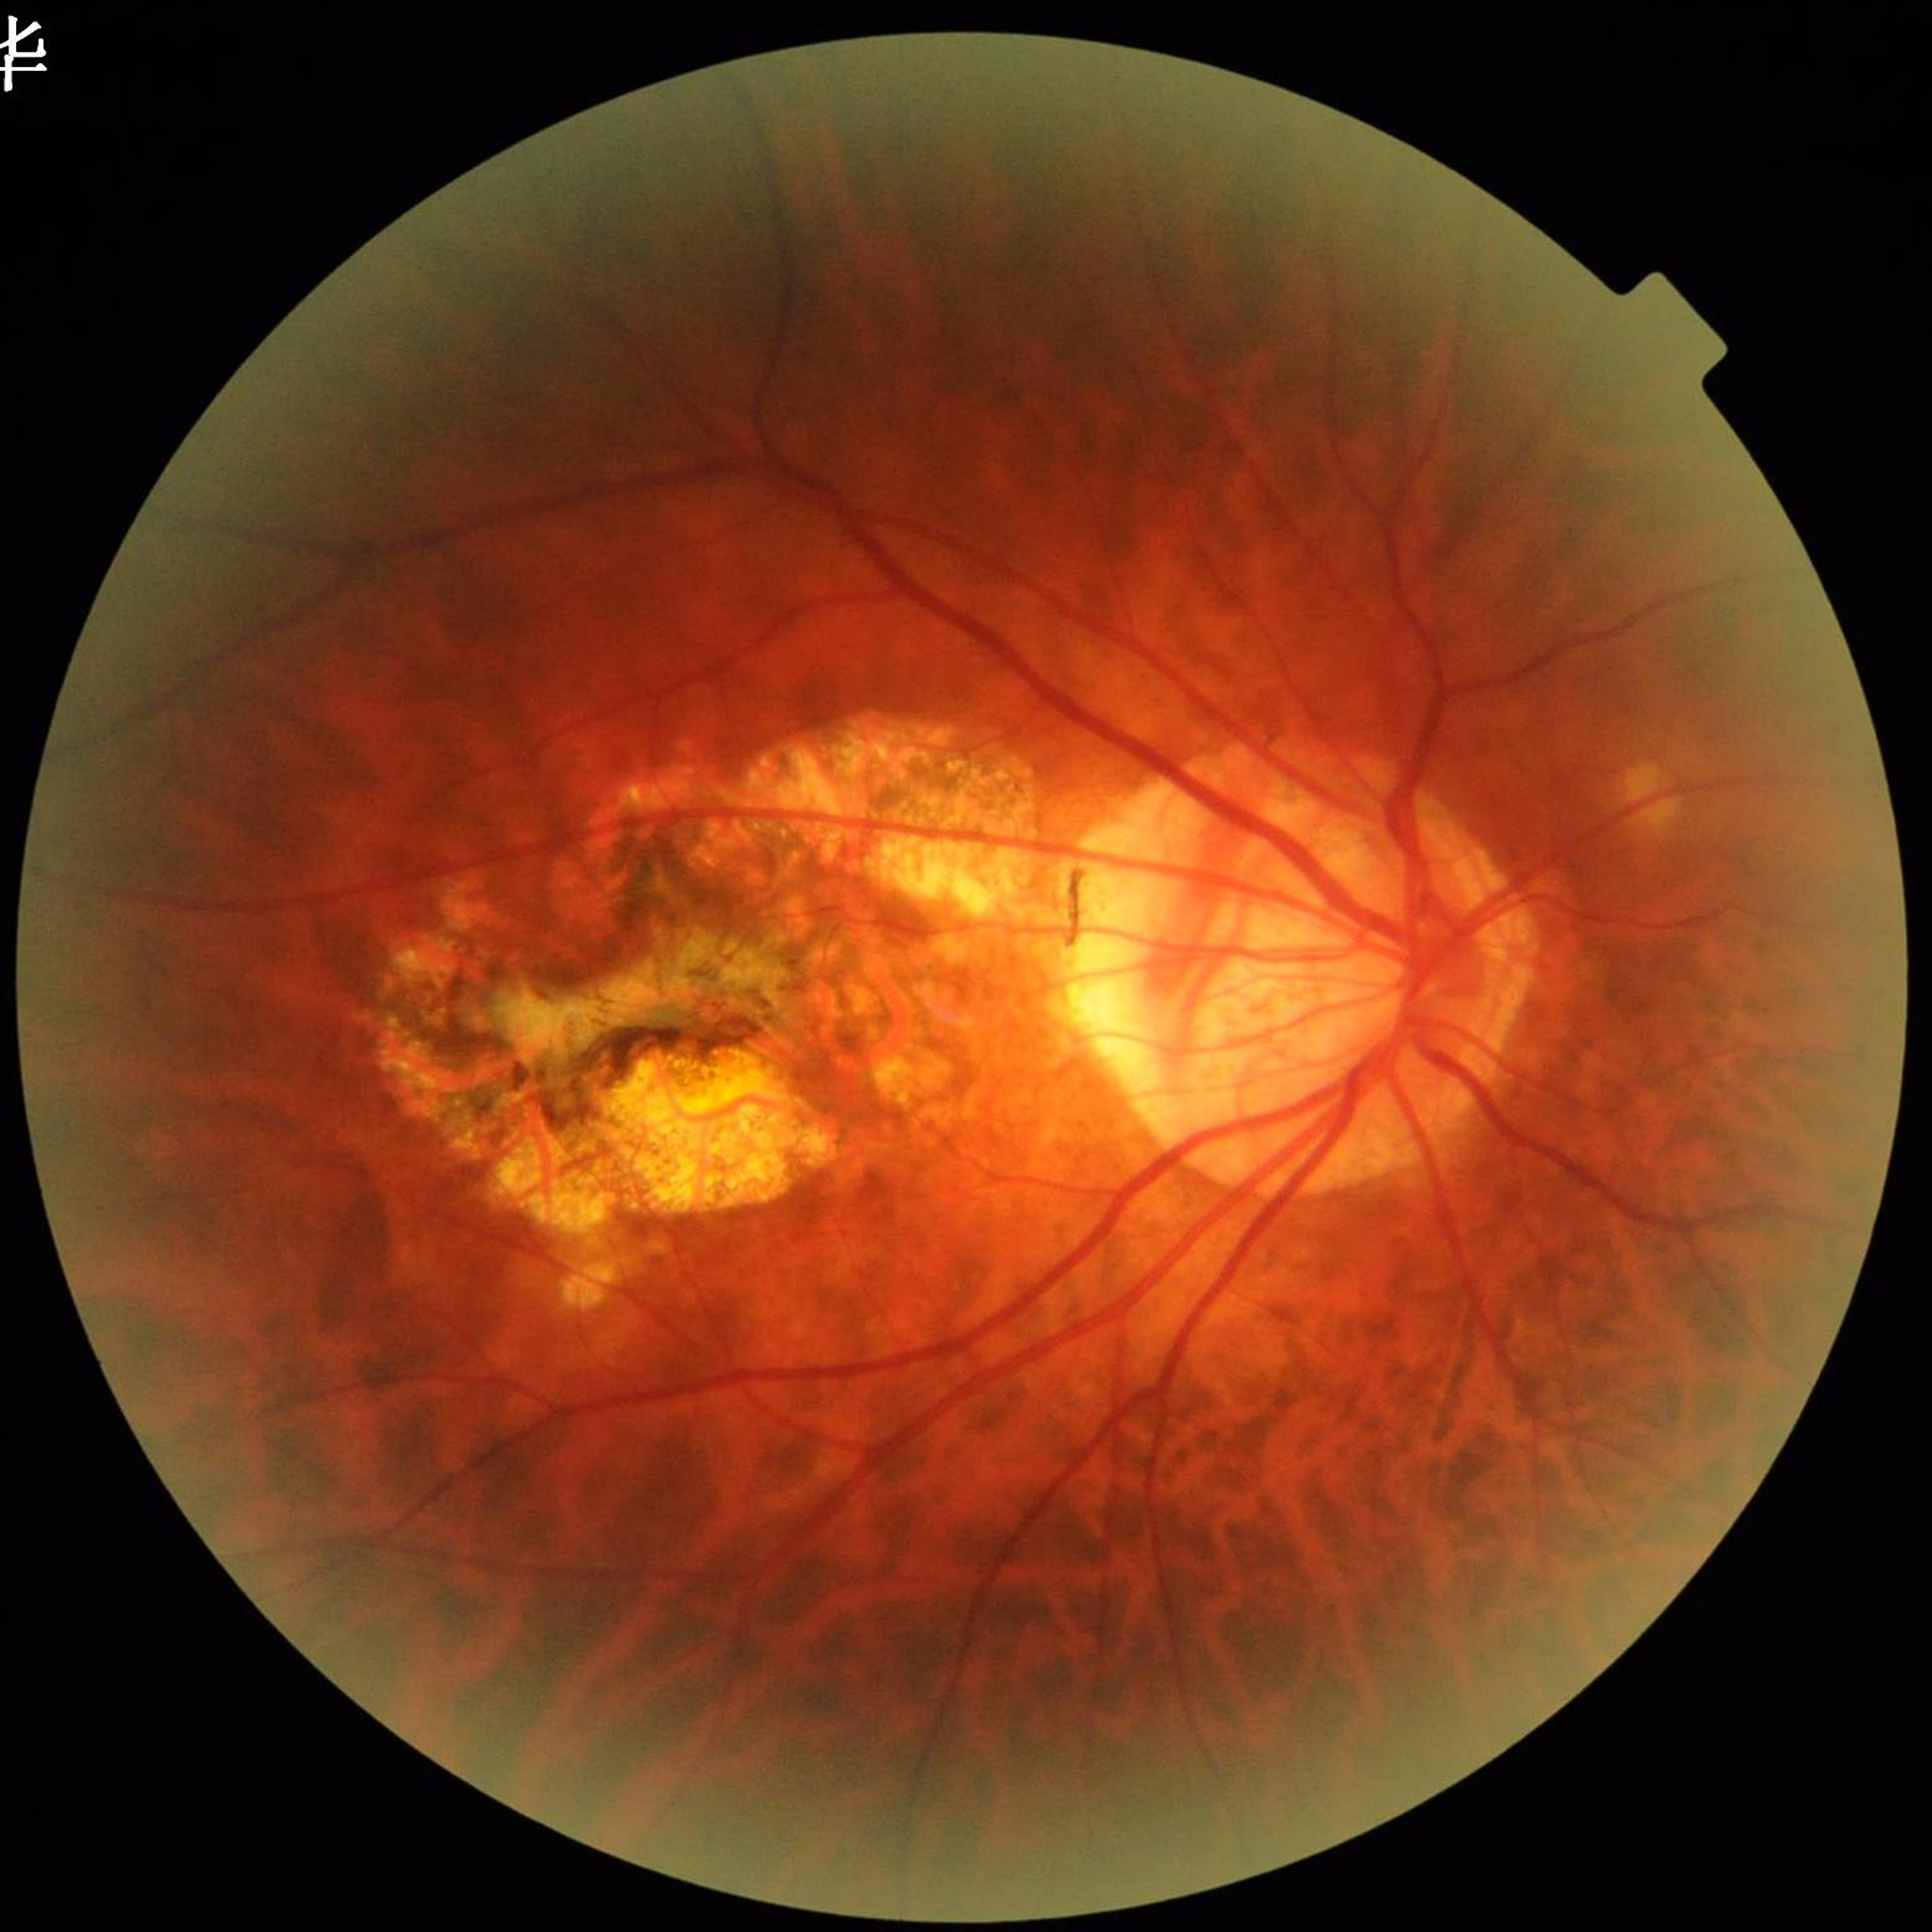

diagnosis: age-related macular degeneration
image_quality: no blur, contrast adequate, illumination/color distortion present